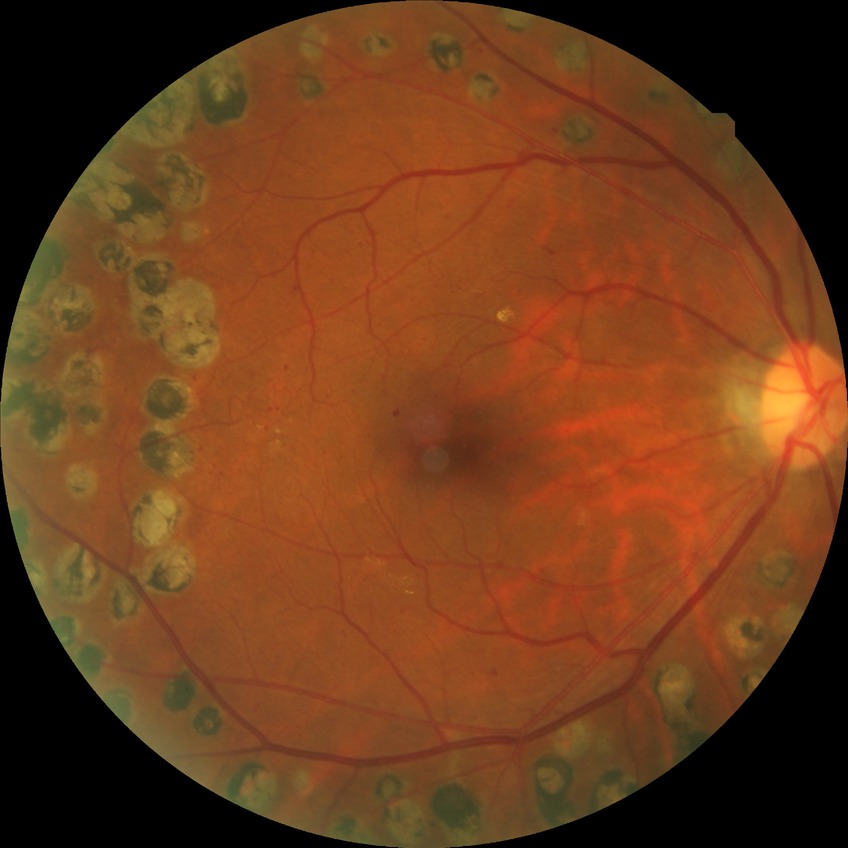

Davis DR grade@PDR.